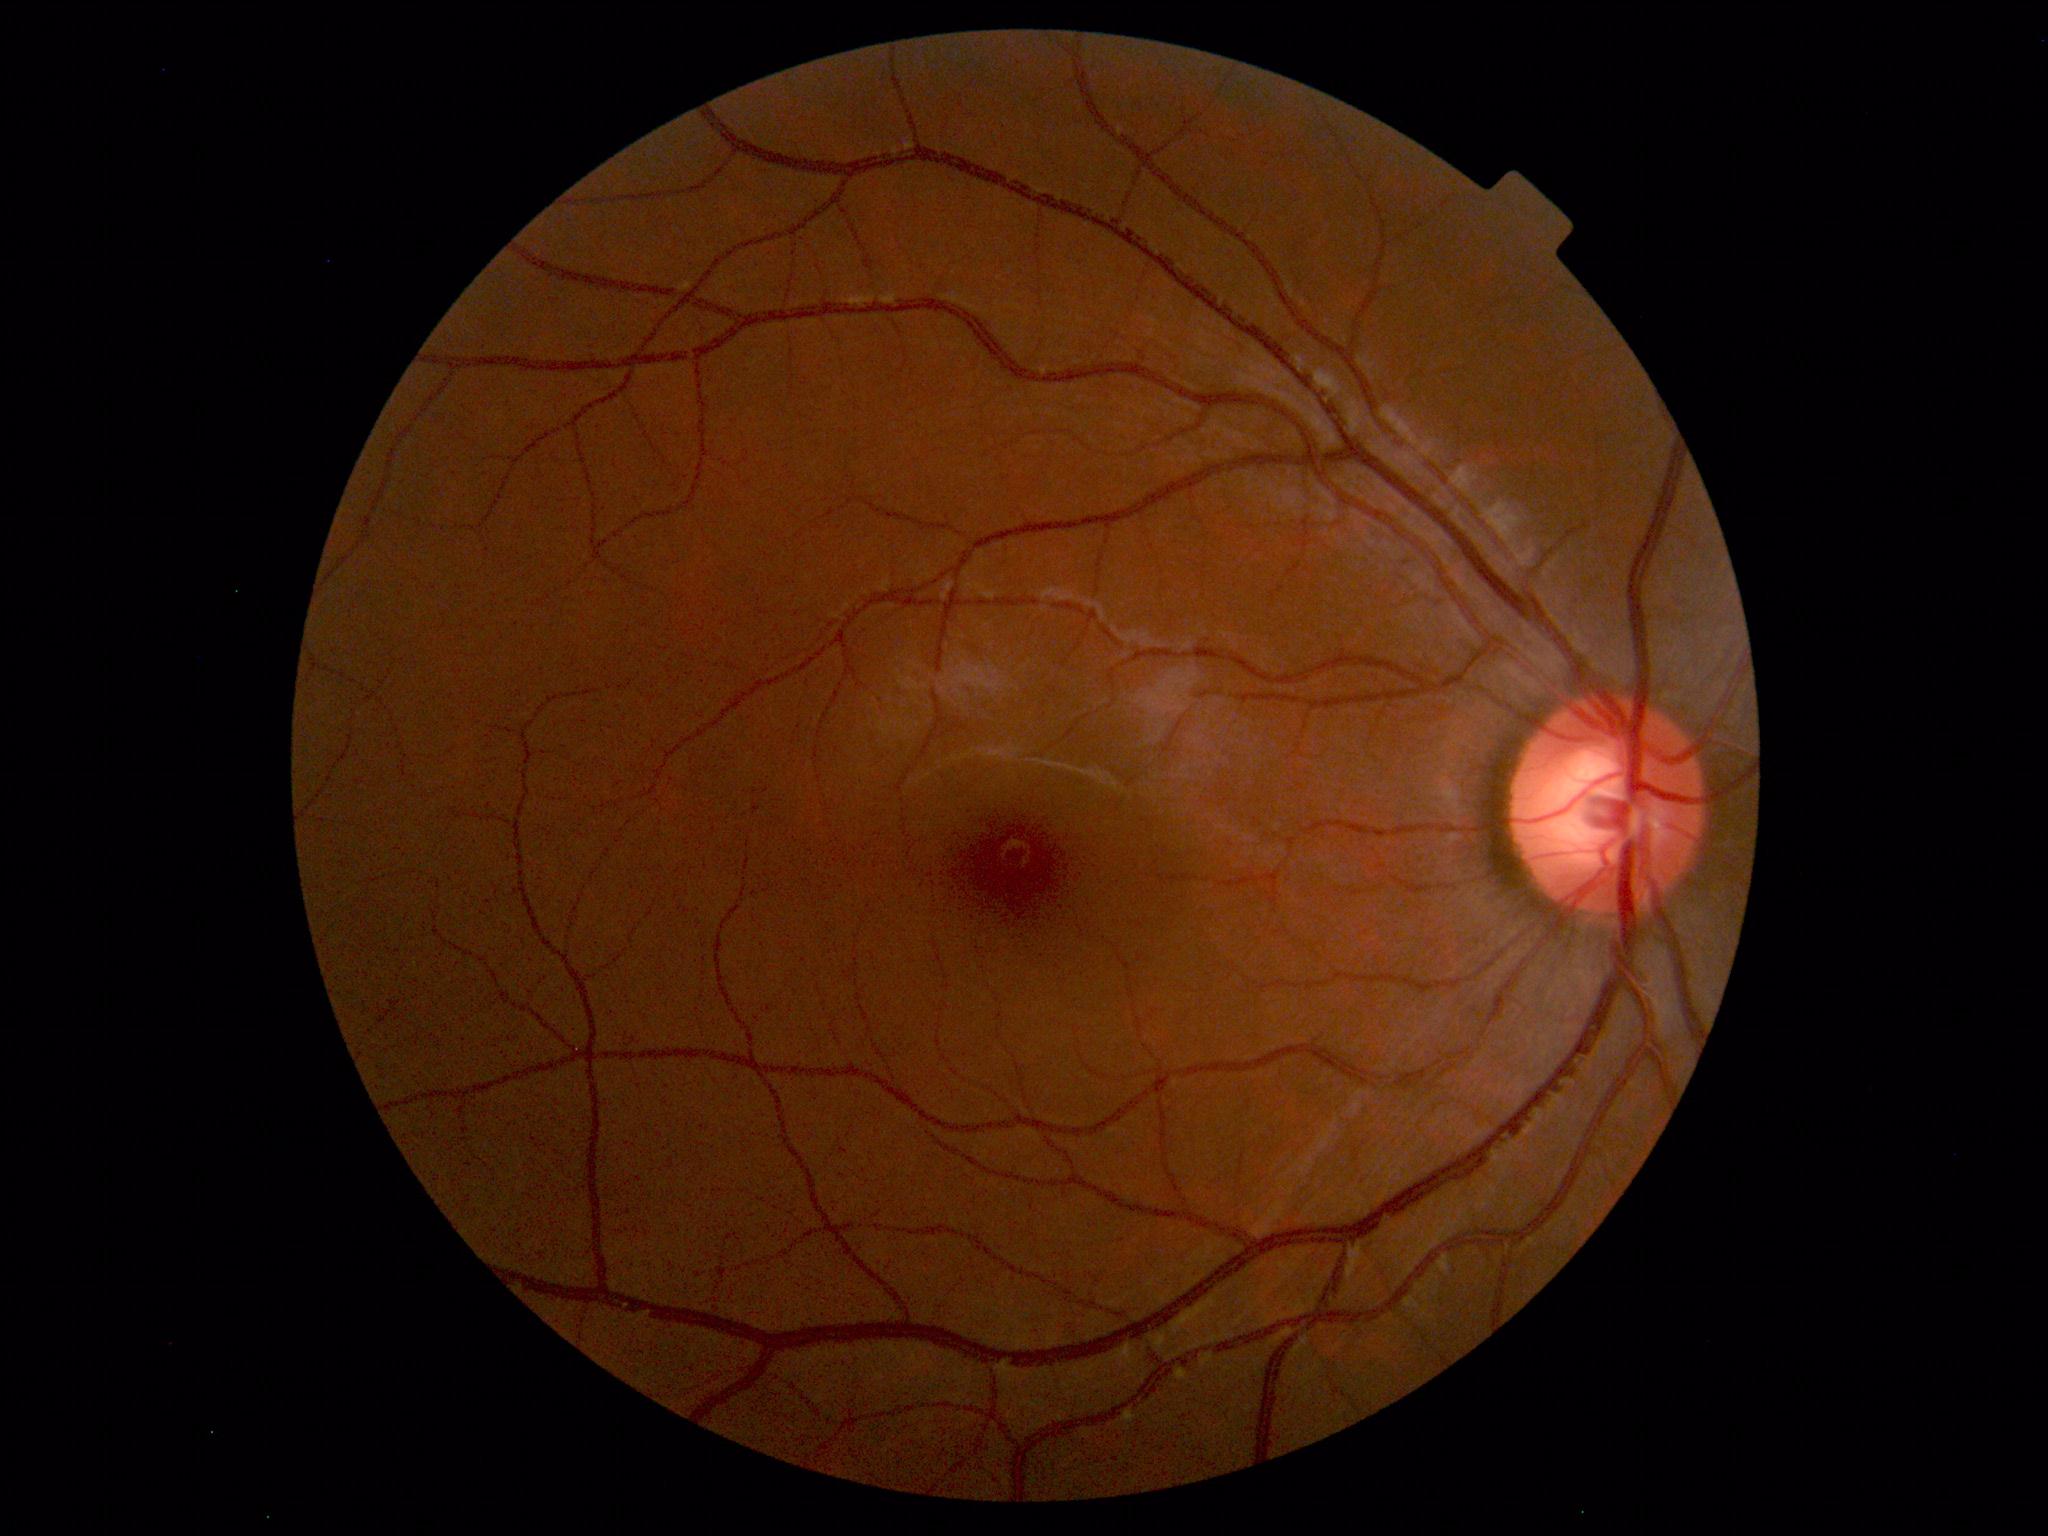 Impression: normal fundus.